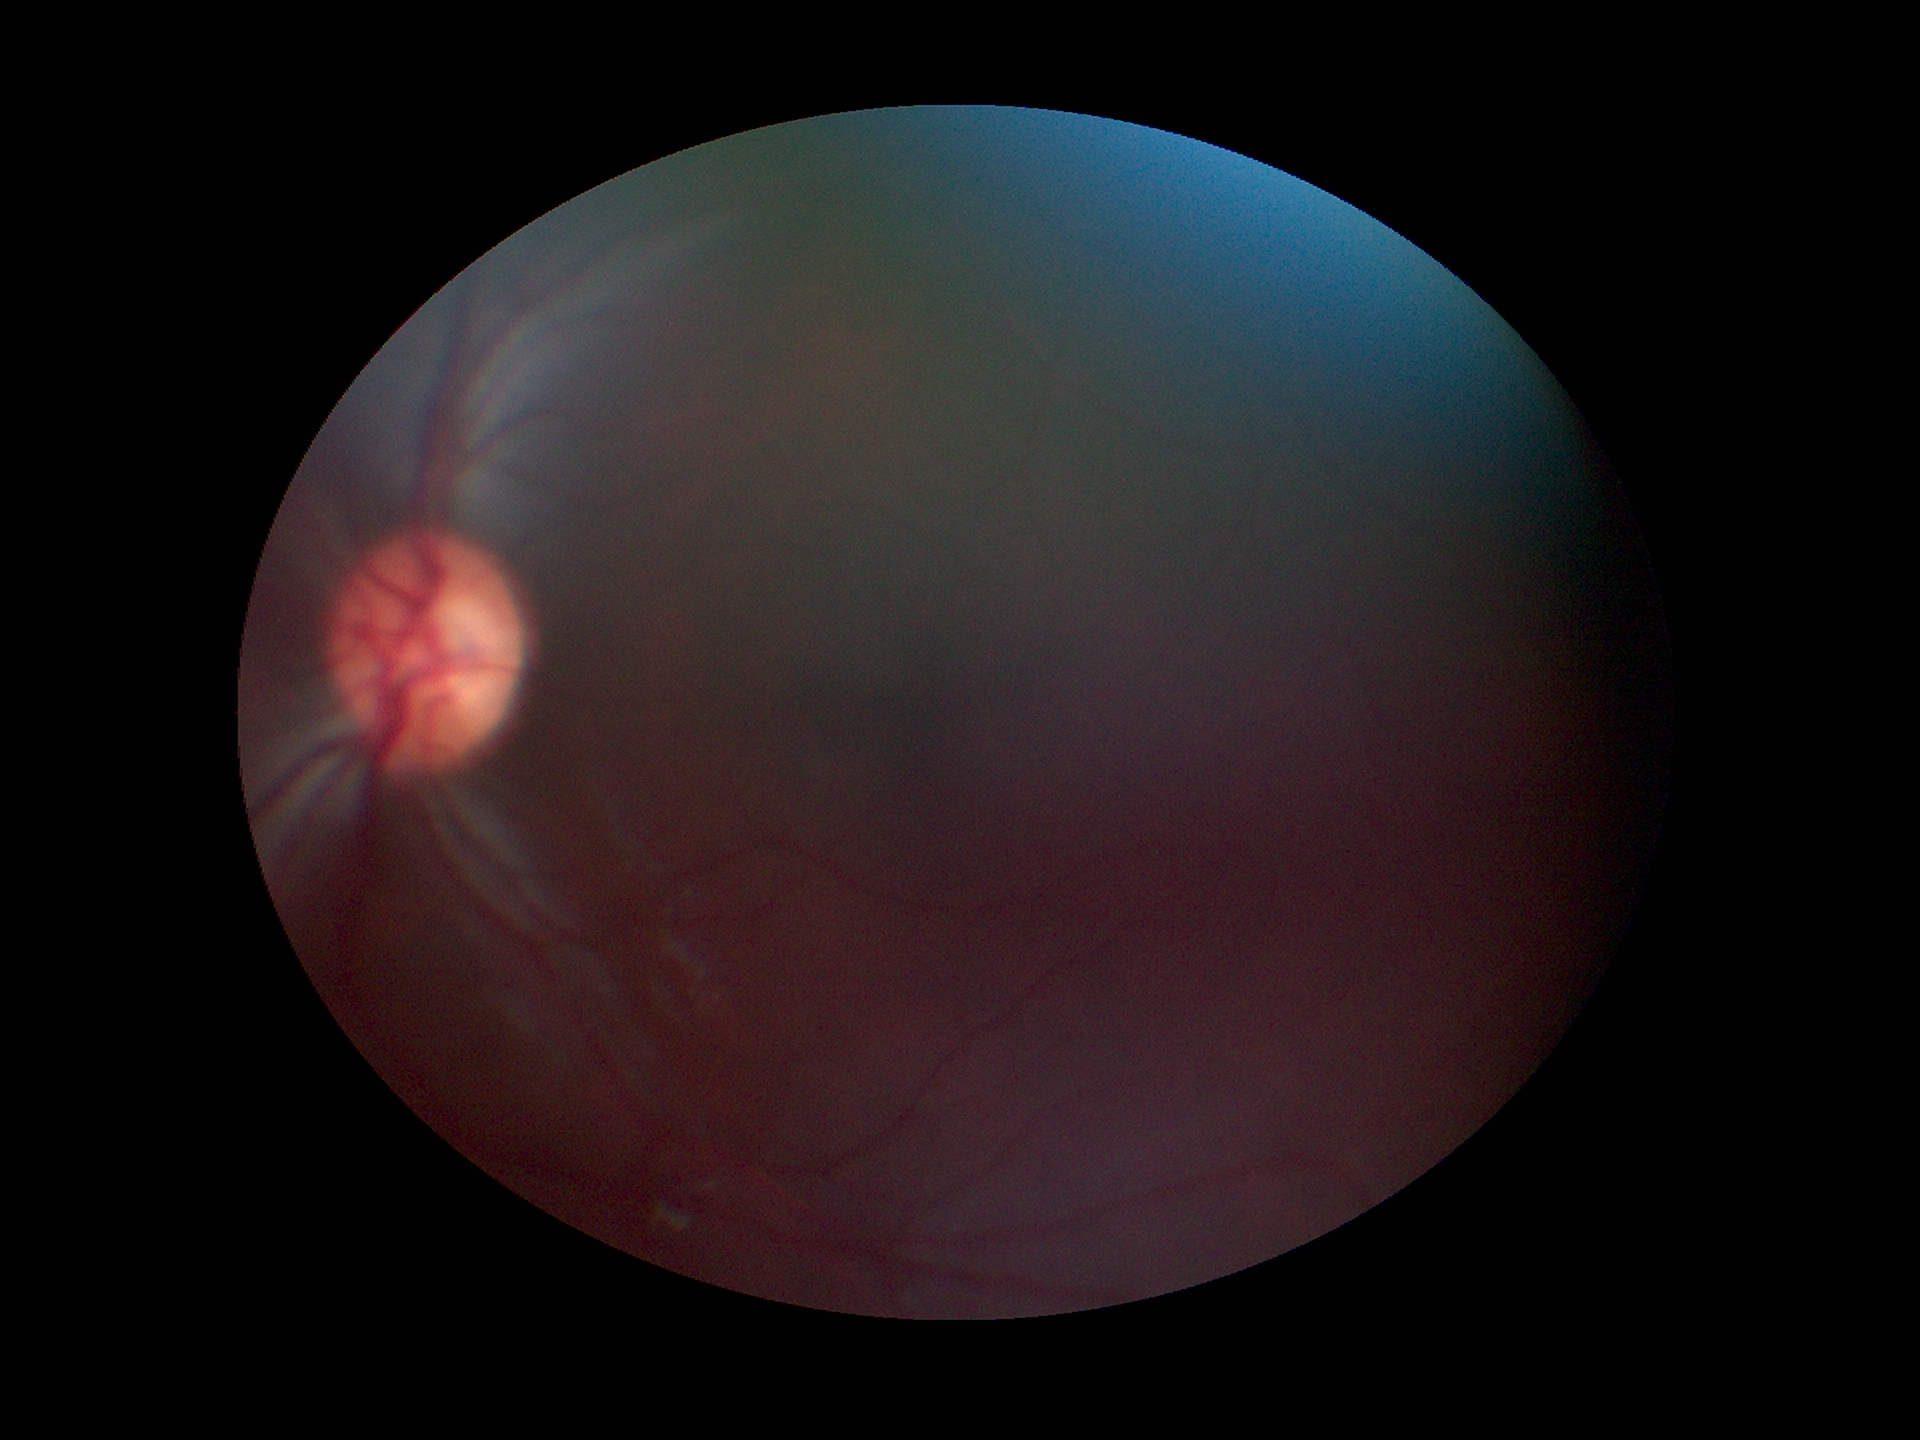
Glaucoma assessment: no suspicious findings.
Vertical C/D ratio: 0.53.